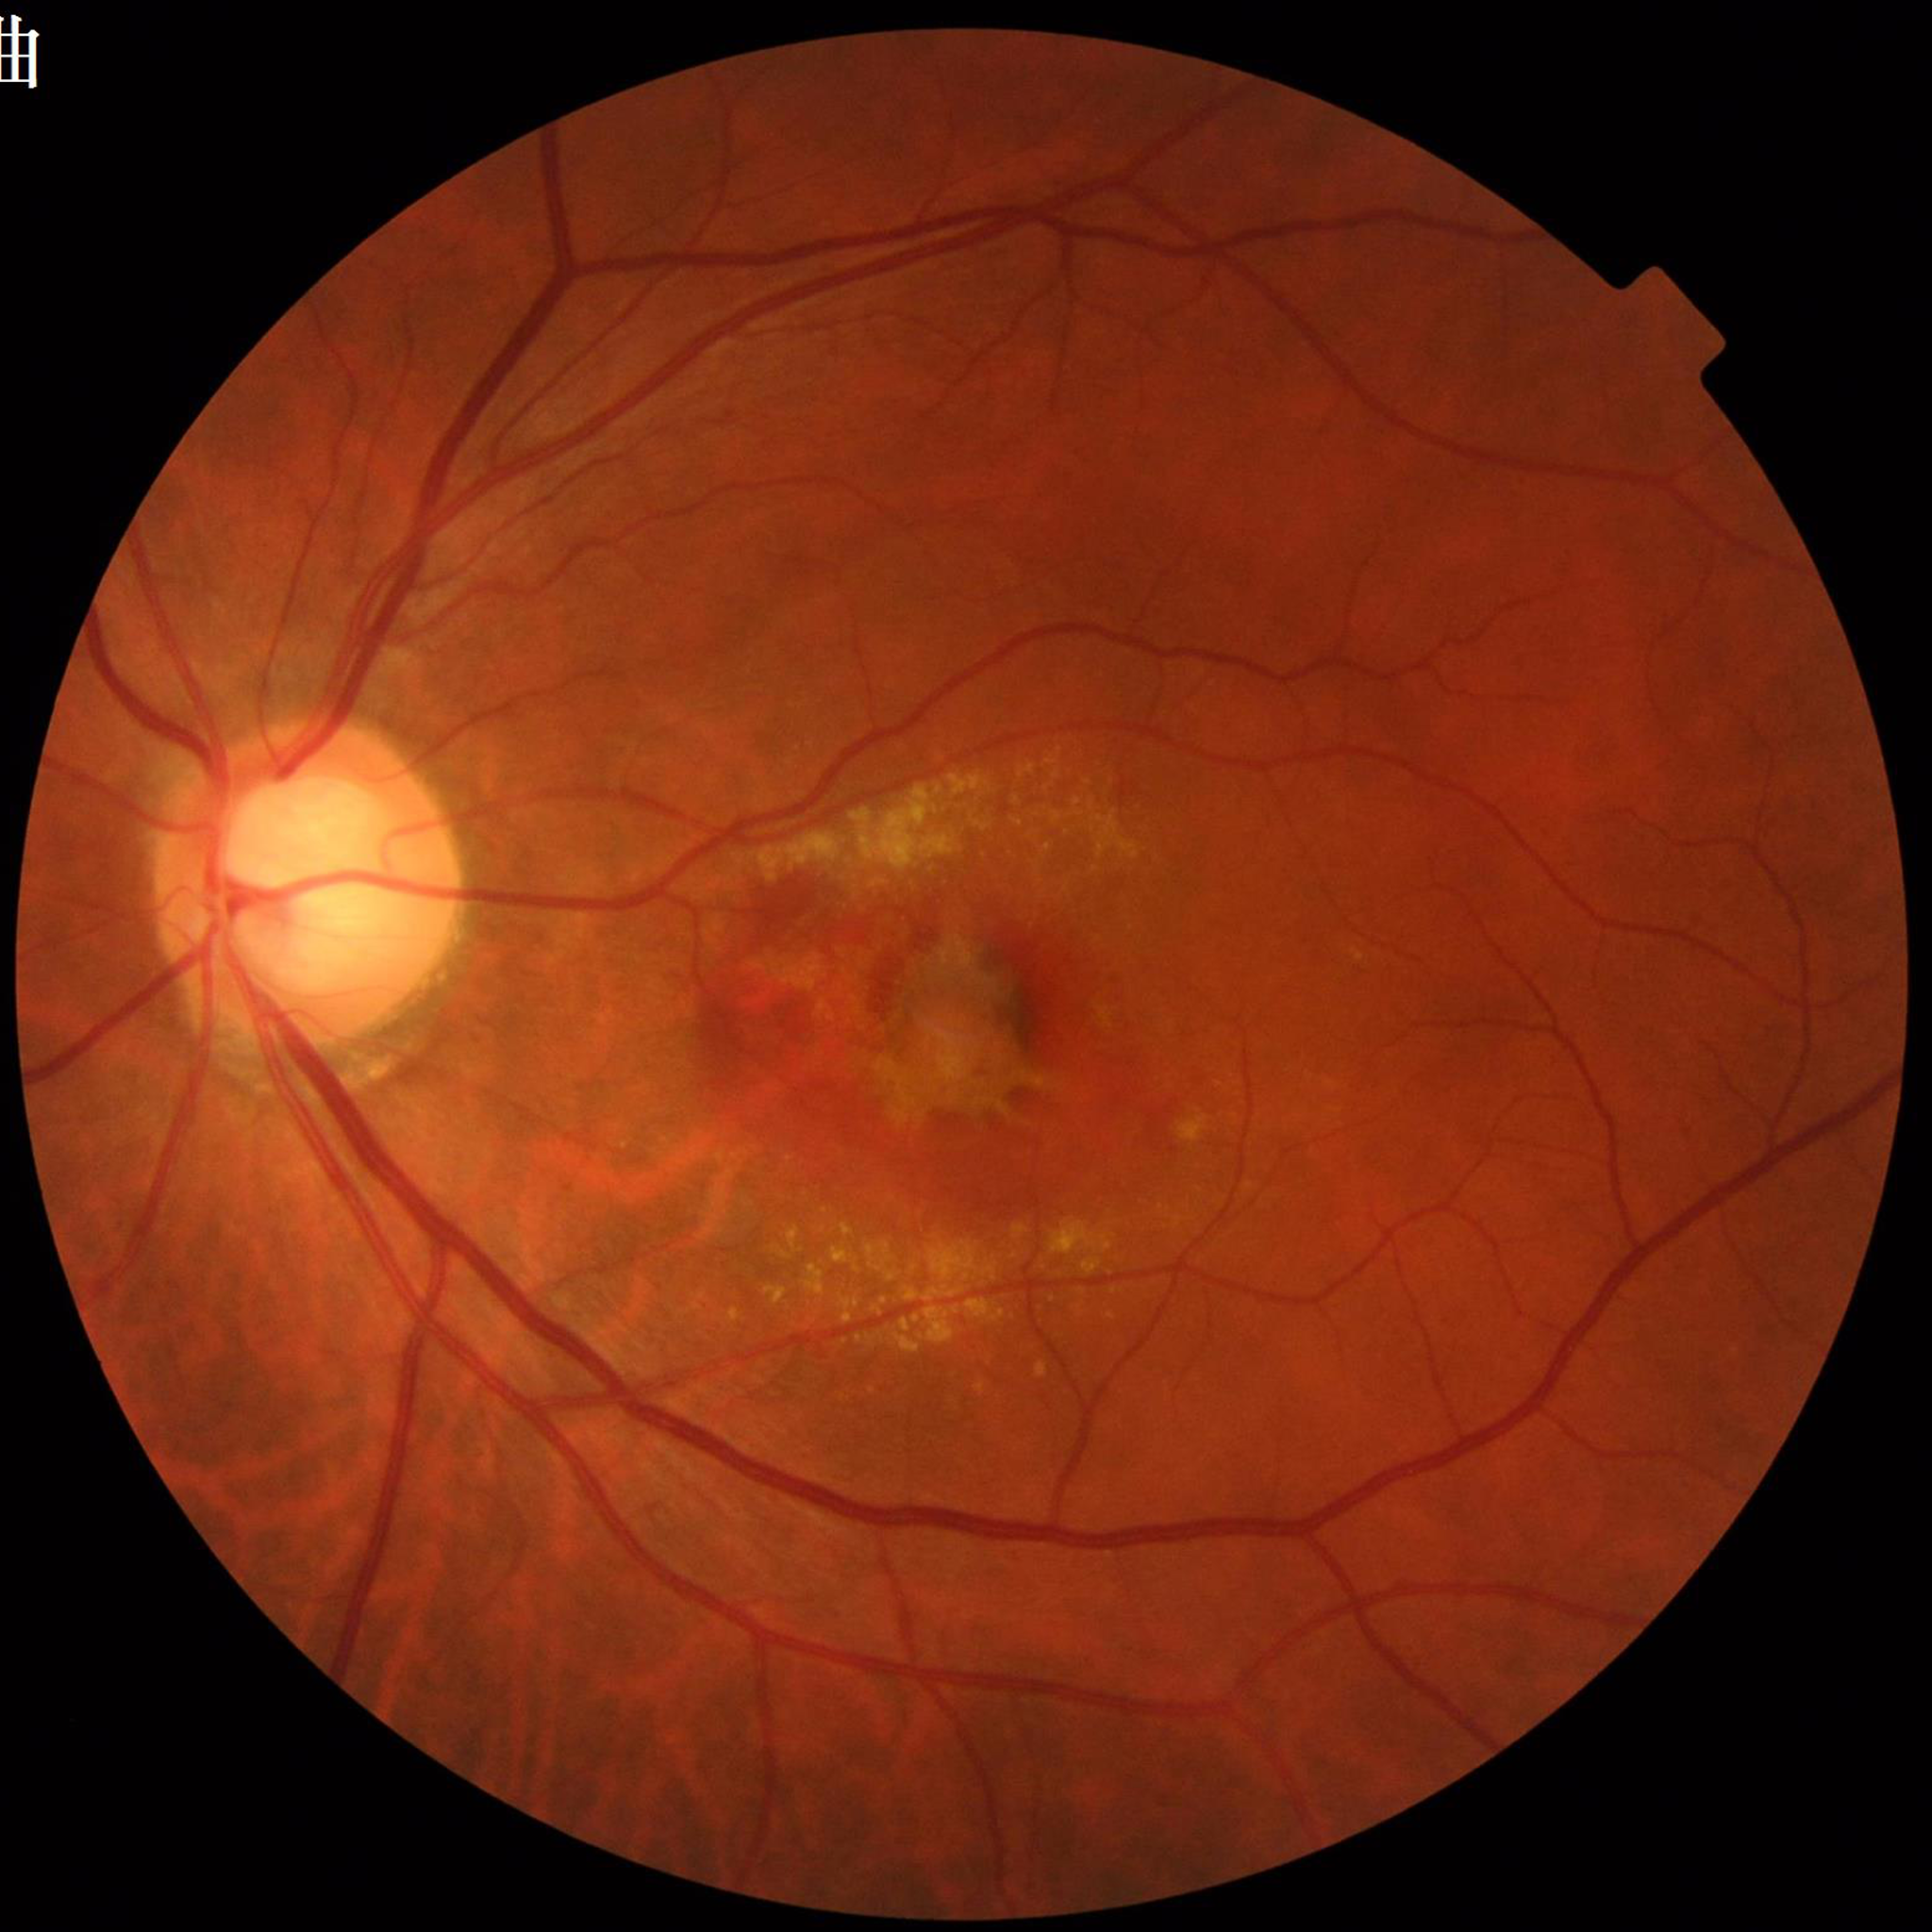 Diagnosis: AMD
Photo quality: no concerns identified